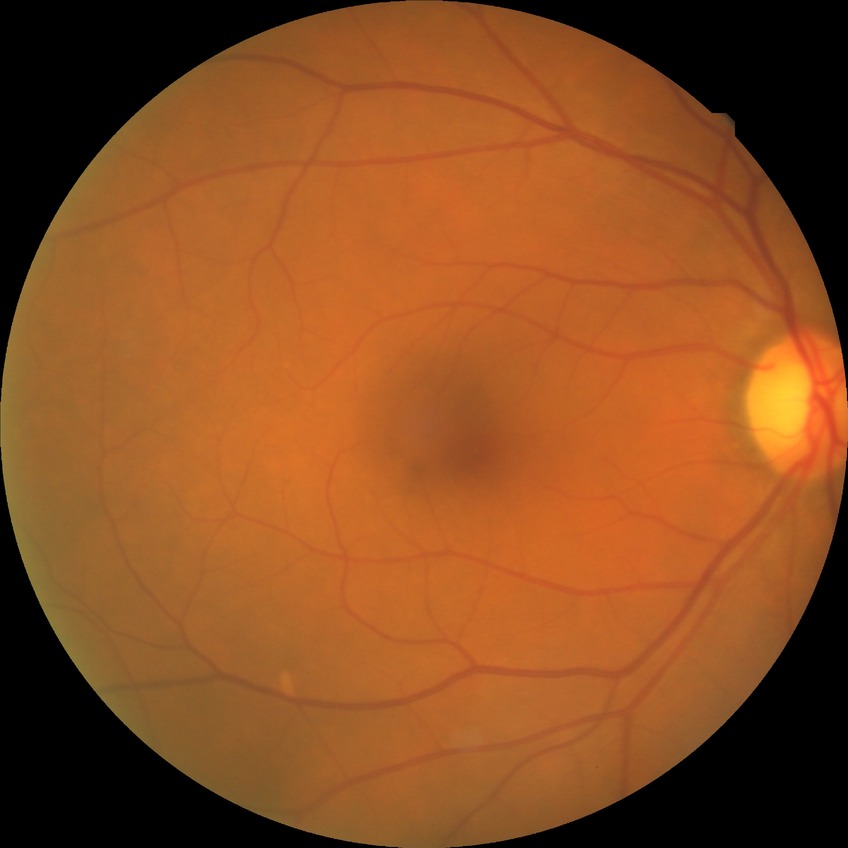

Diabetic retinopathy (DR) is no diabetic retinopathy (NDR).